Wide-field fundus image from infant ROP screening:
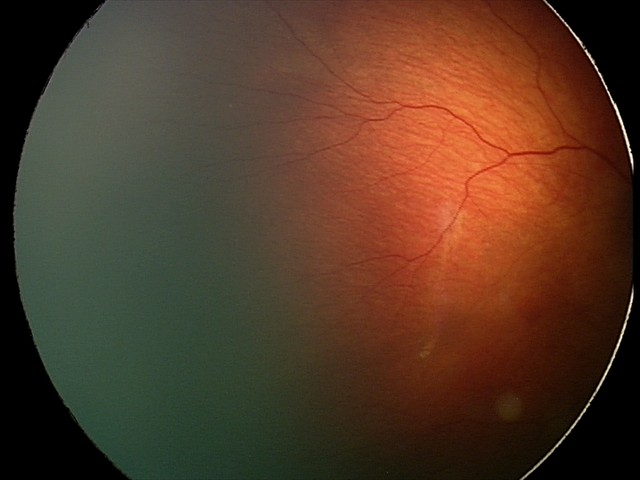 Screening examination consistent with status post ROP.
Without plus disease.